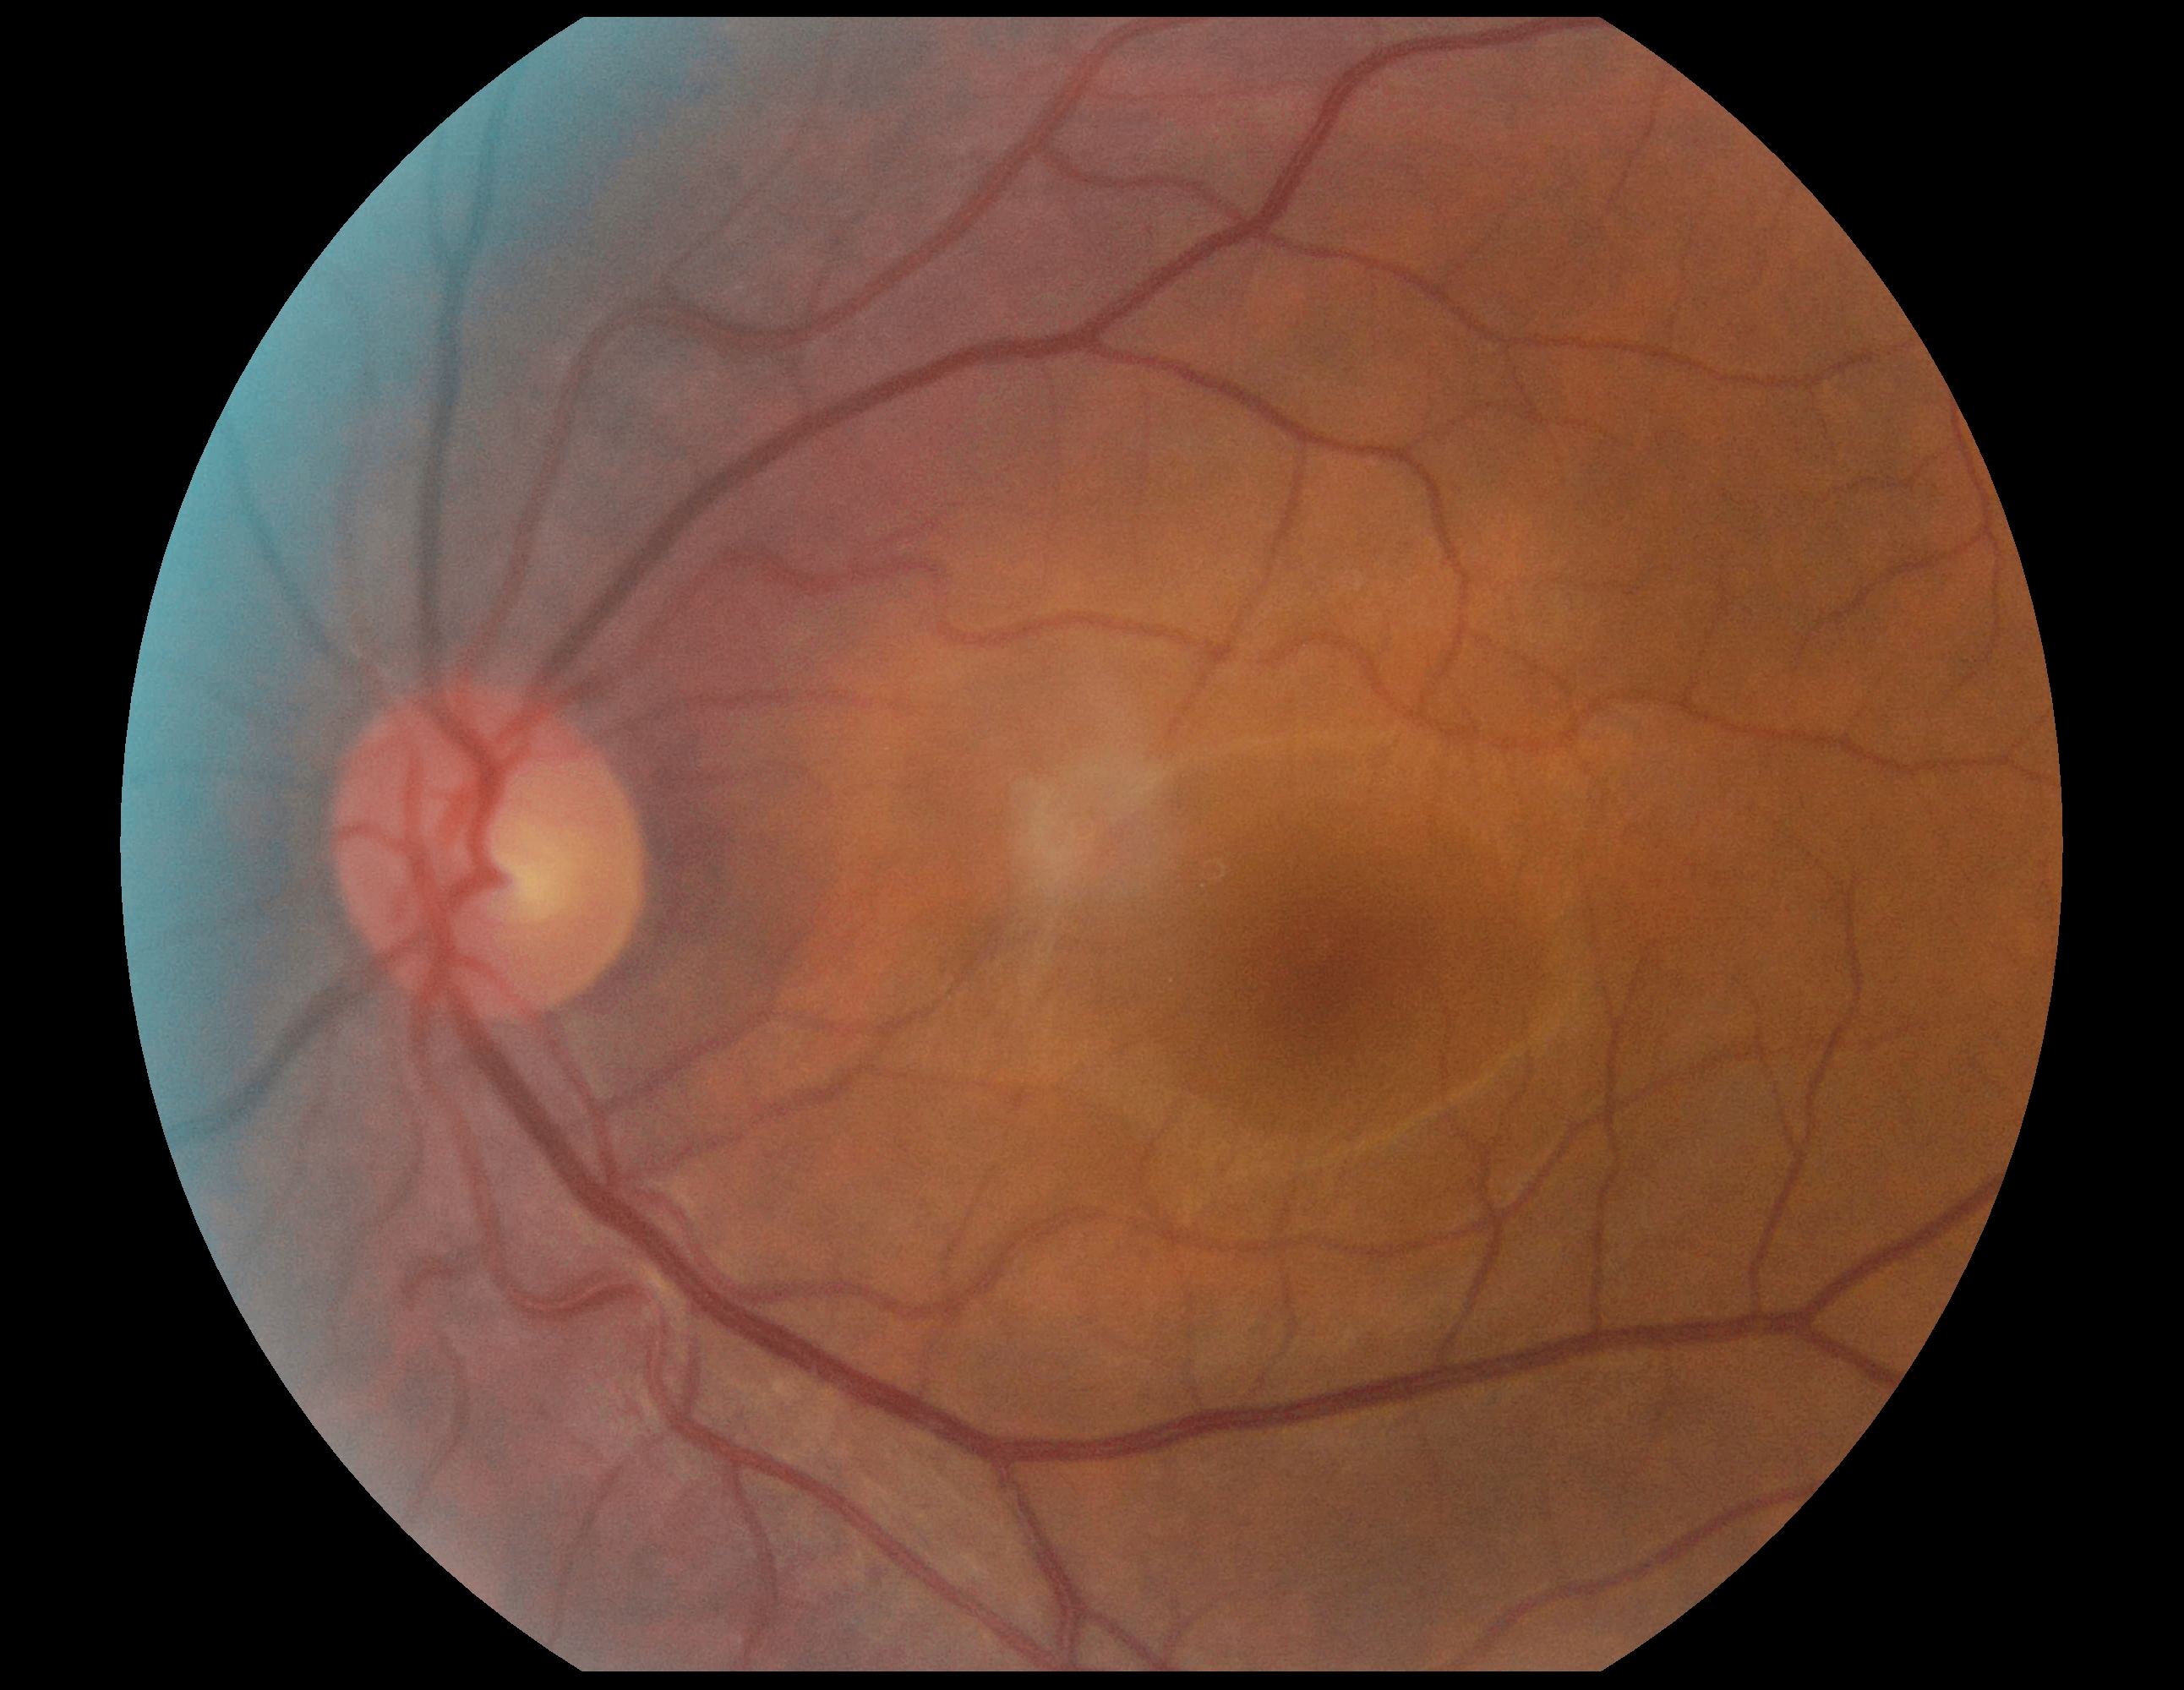
DR severity is no apparent retinopathy (grade 0).